2352x1568px: 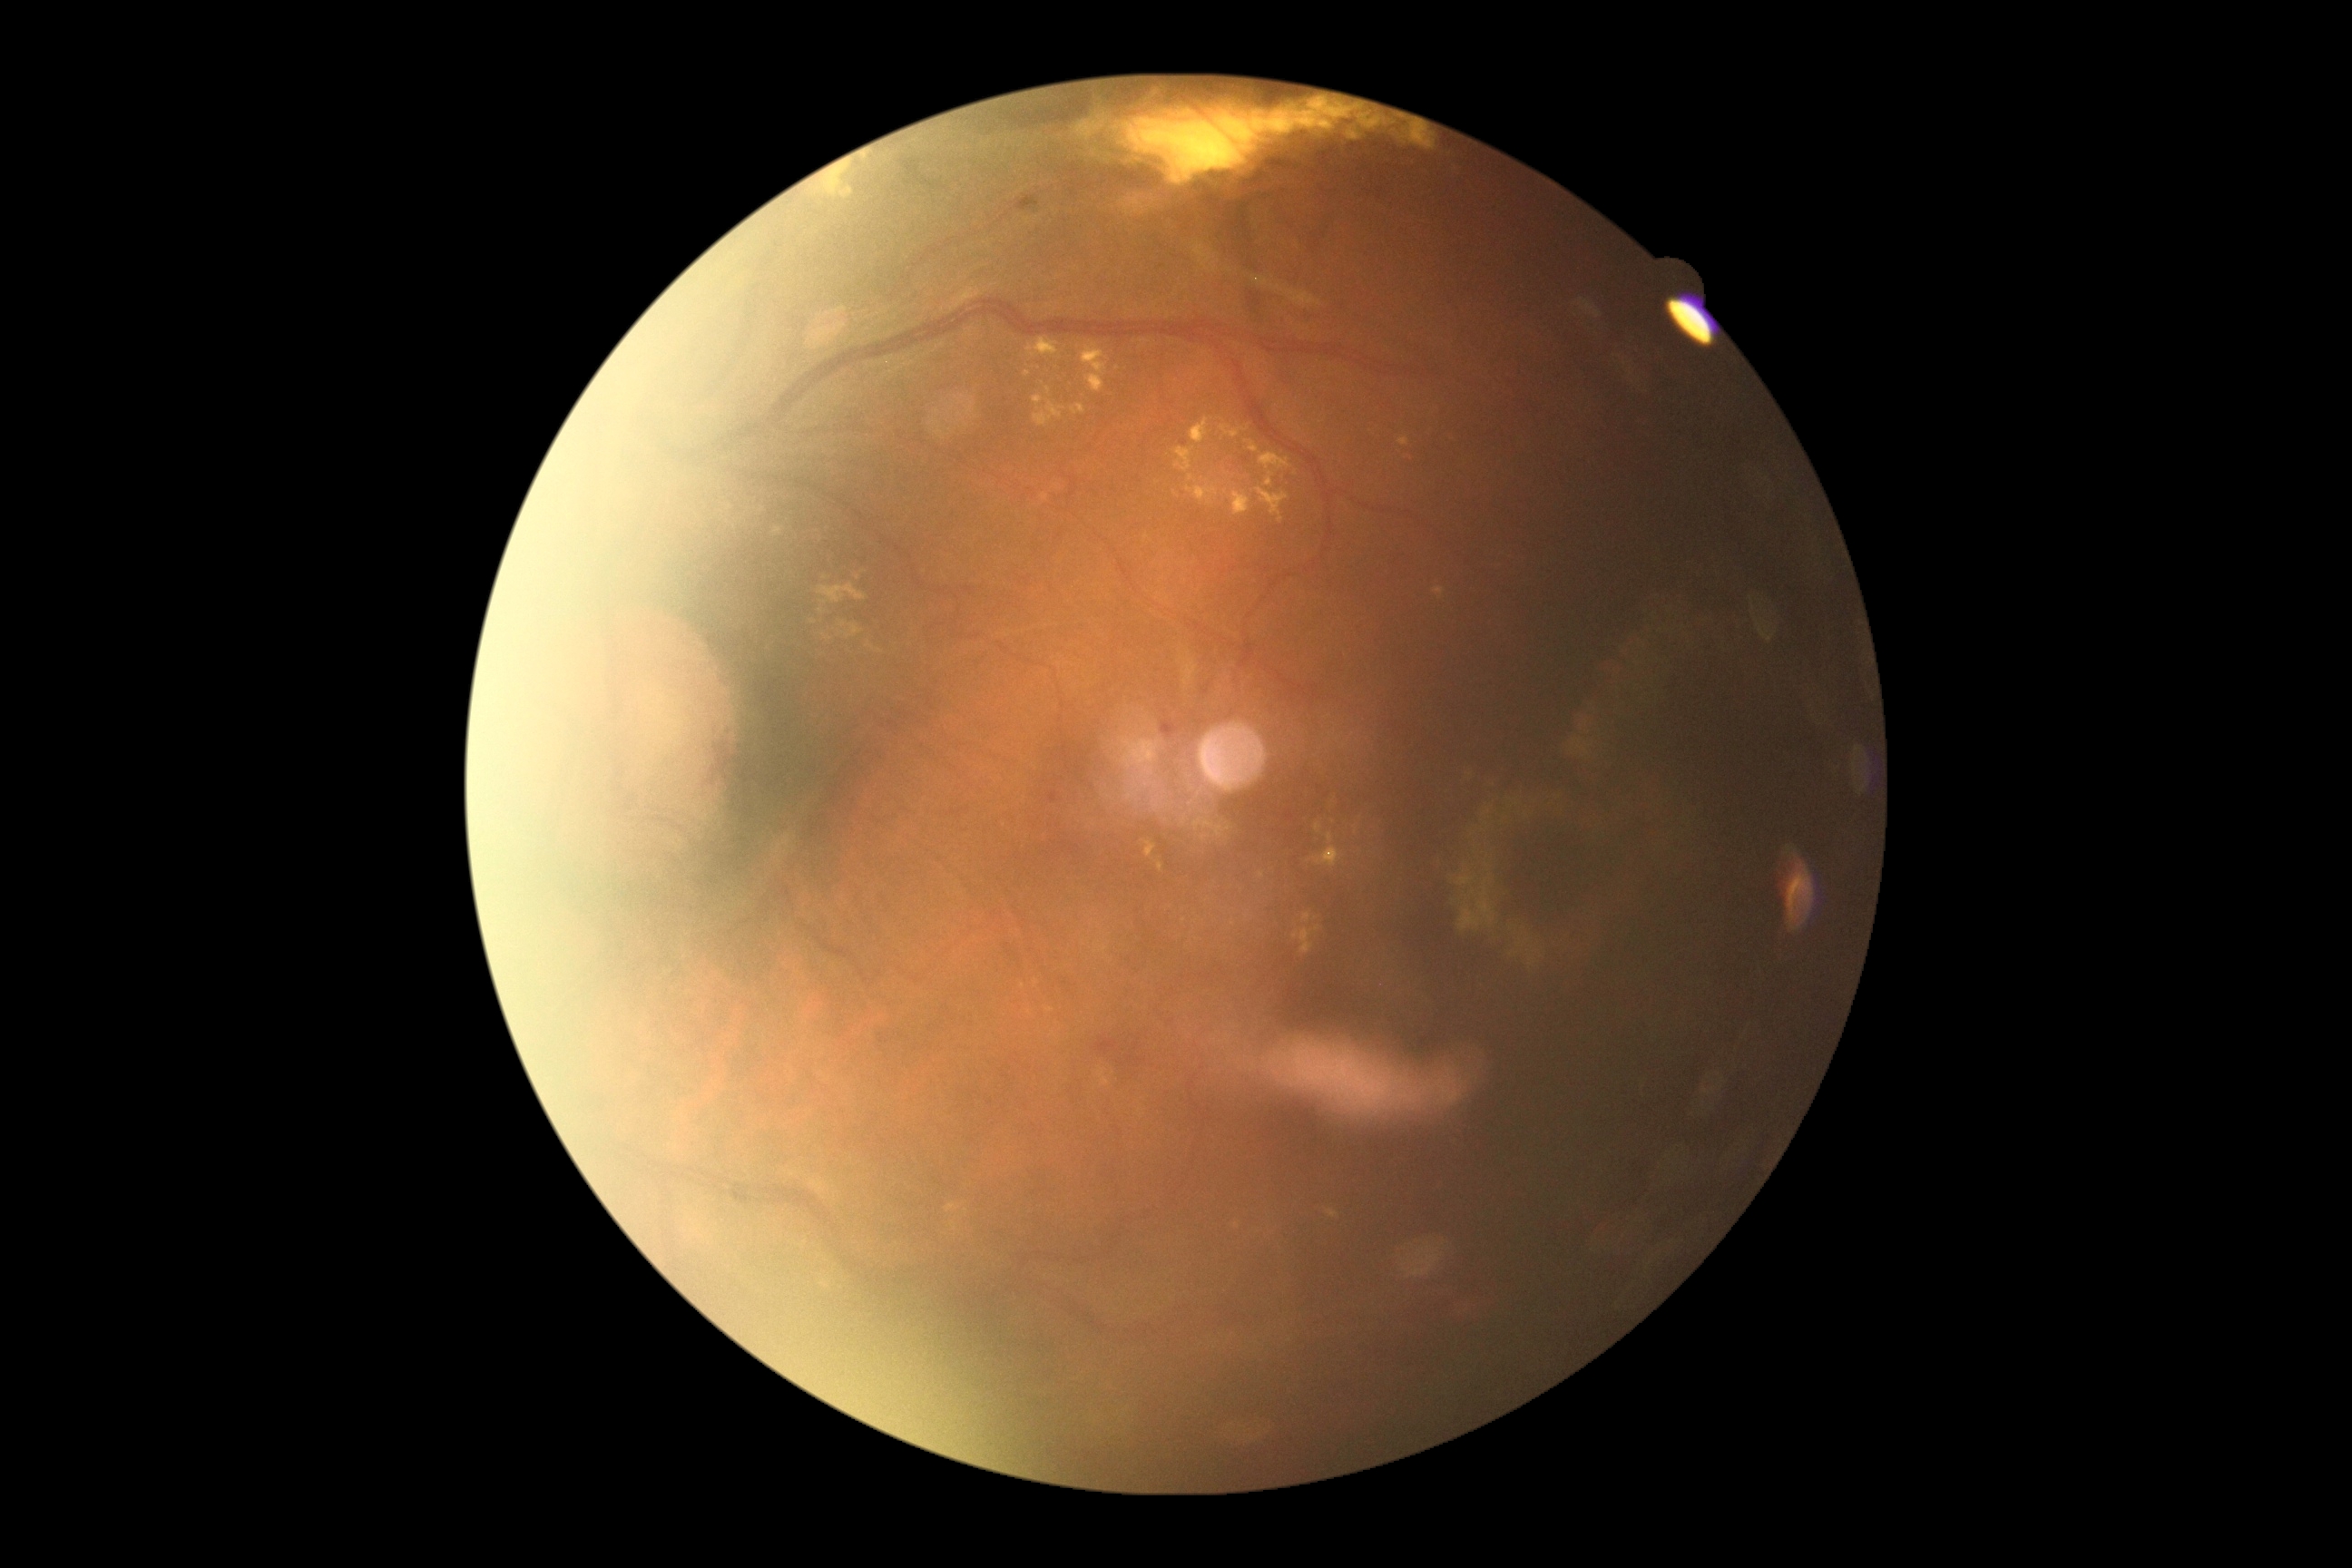 Annotations:
– DR — moderate NPDR (grade 2)